2346 by 1568 pixels — 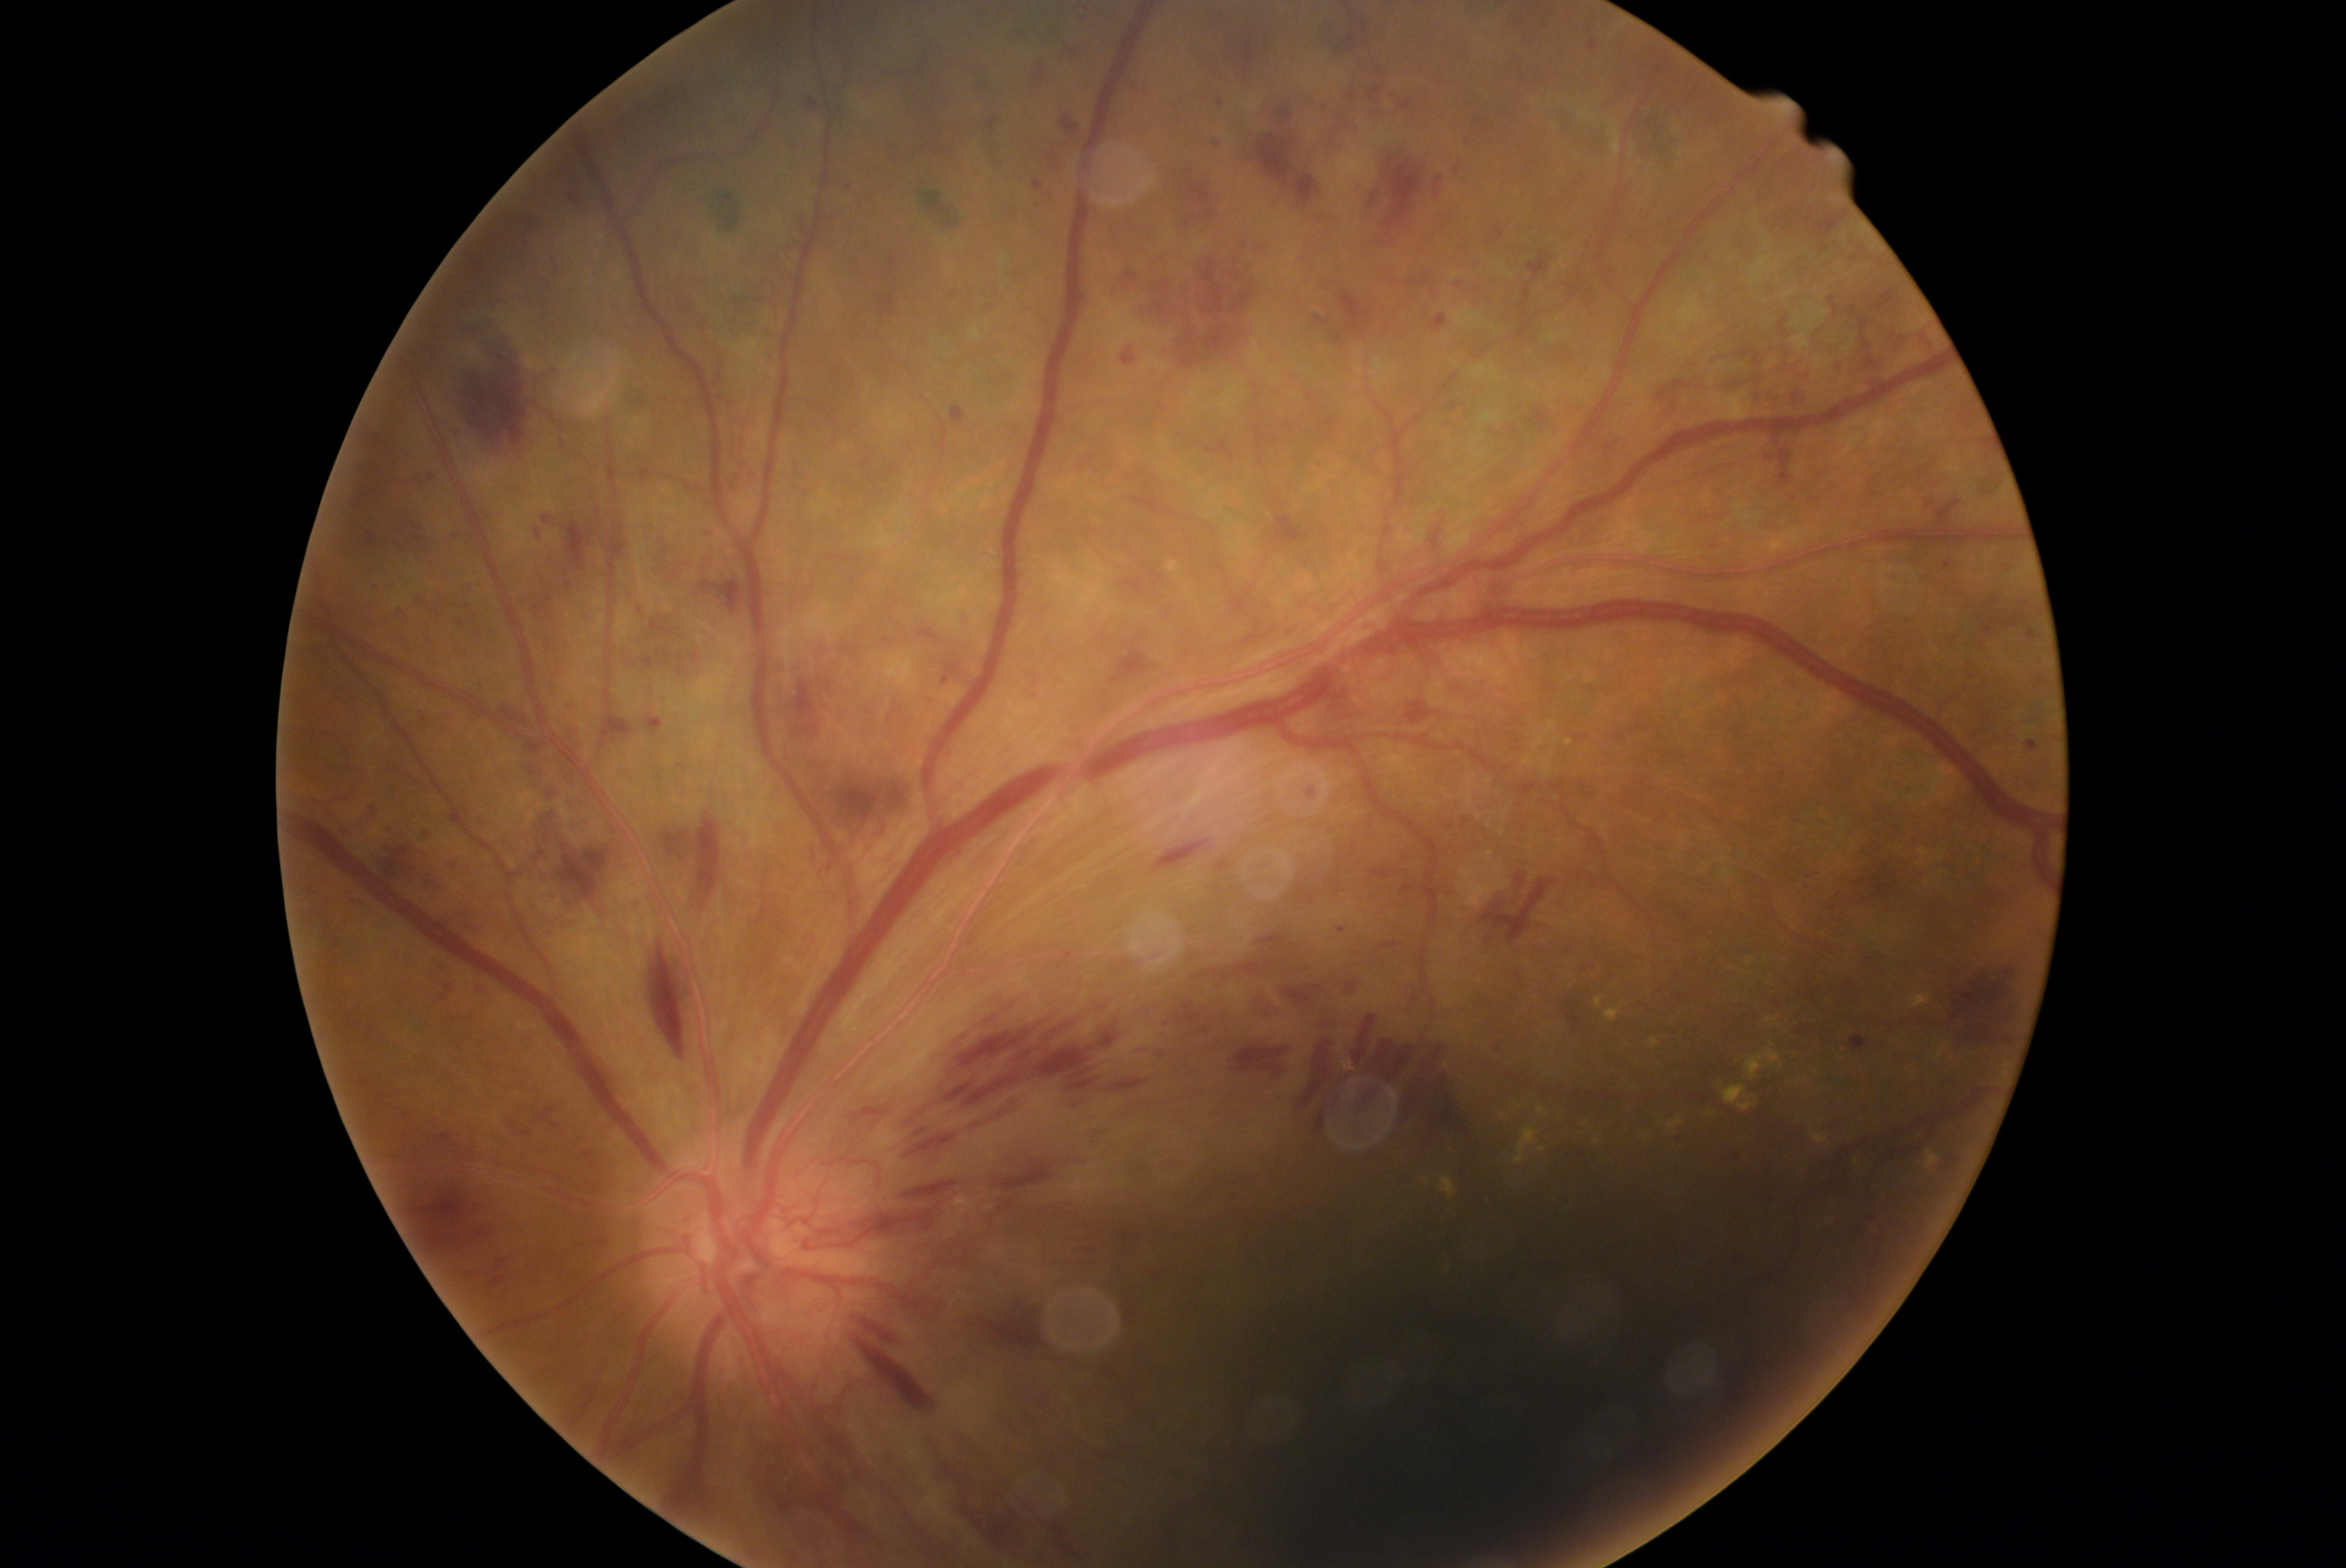

  dr_grade: grade 4 (PDR)